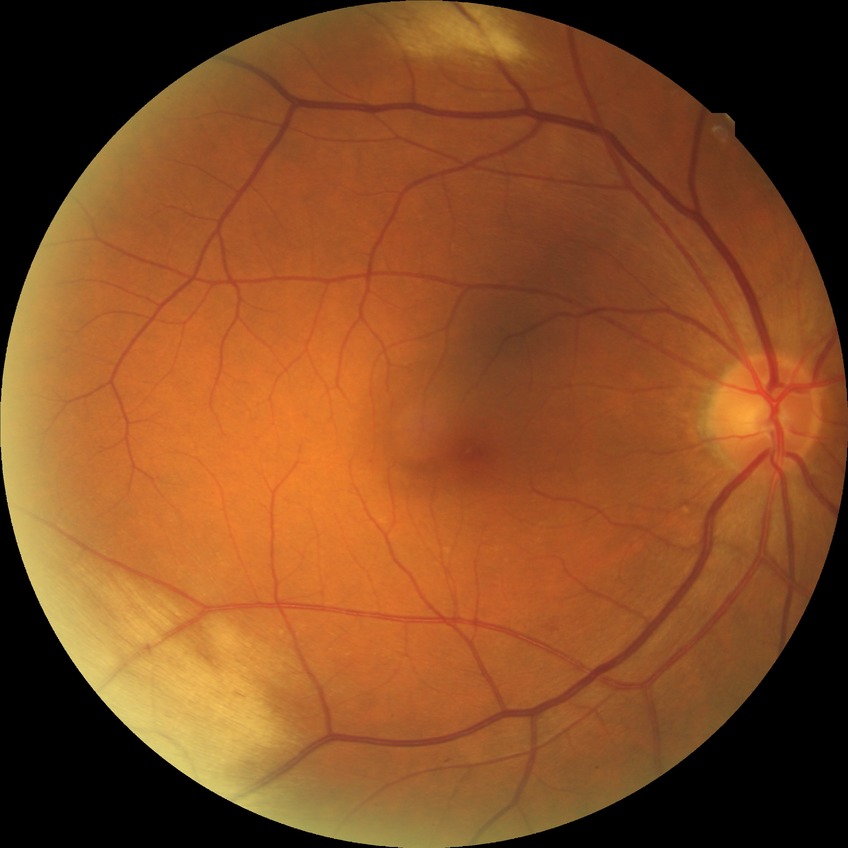 davis_grade: simple diabetic retinopathy (SDR)
proliferative_class: non-proliferative diabetic retinopathy